Image size 1240x1240 · wide-field fundus image from infant ROP screening.
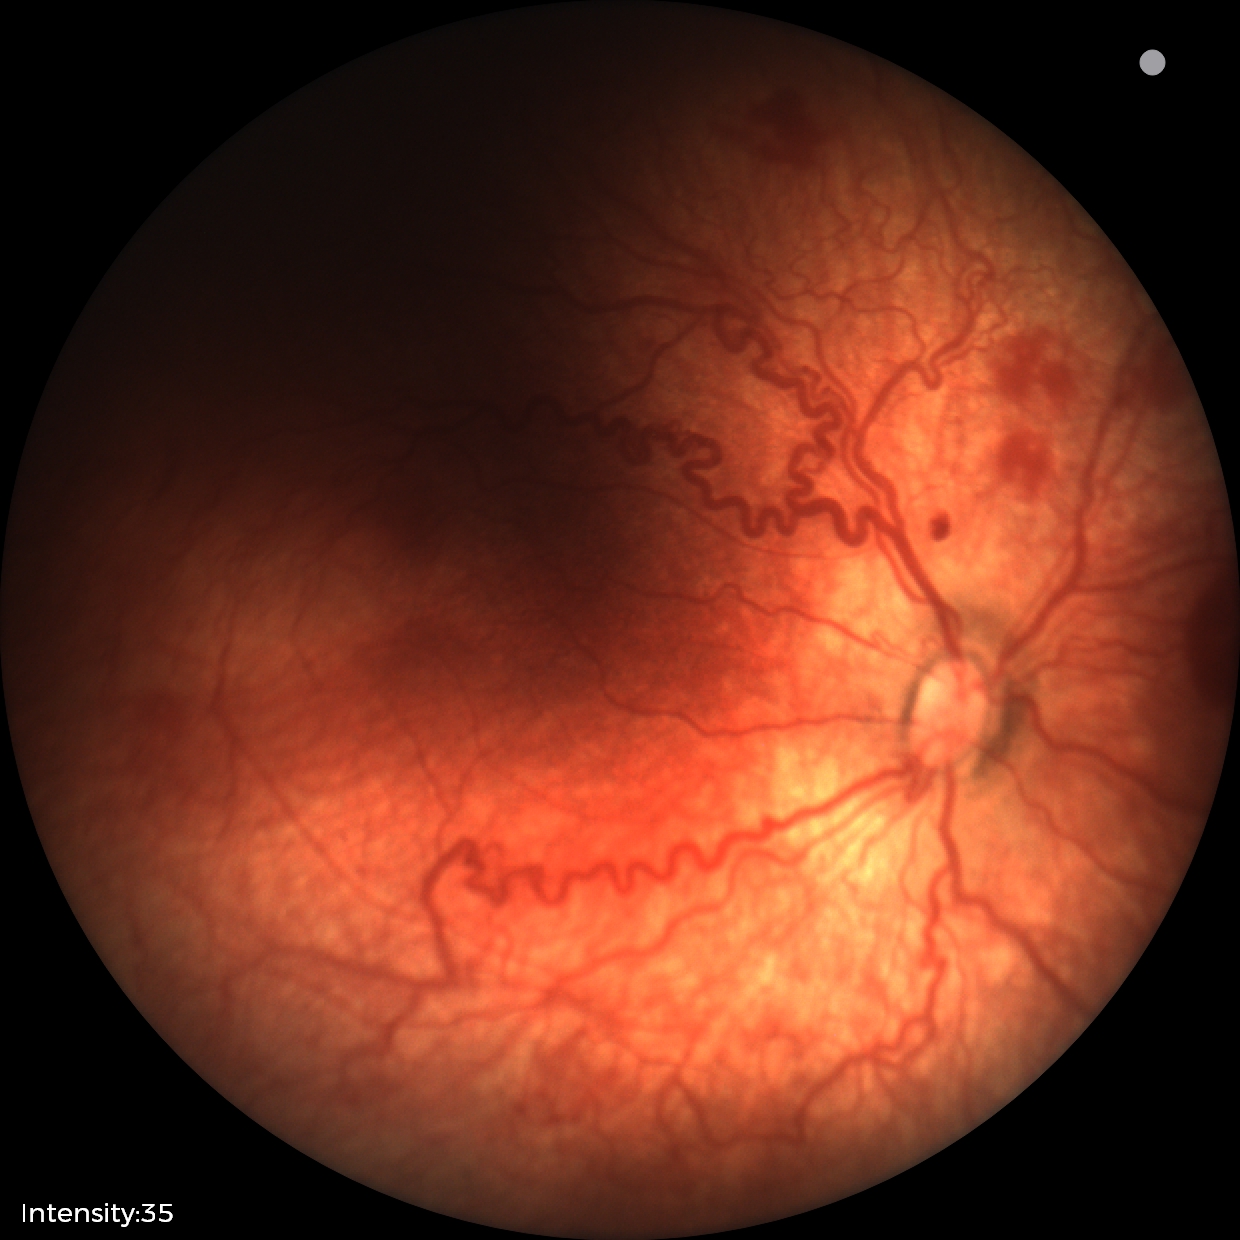

Impression: ROP stage 2 — ridge with height and width at the demarcation line; plus disease.